FOV: 45 degrees. Posterior pole photograph:
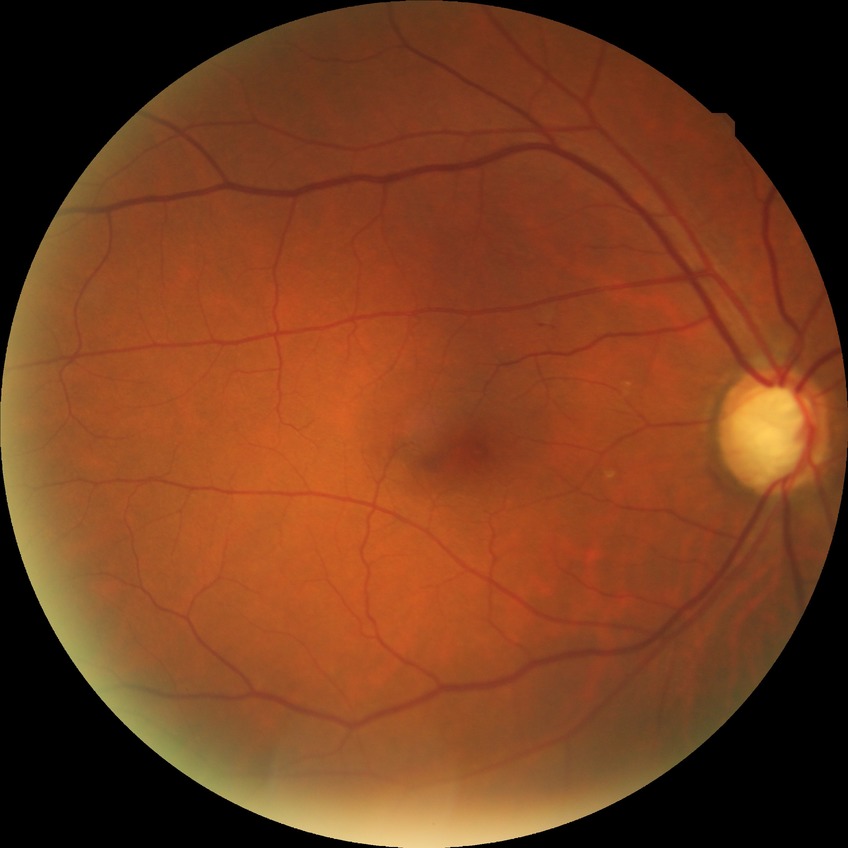 davis_grade: NDR (no diabetic retinopathy)